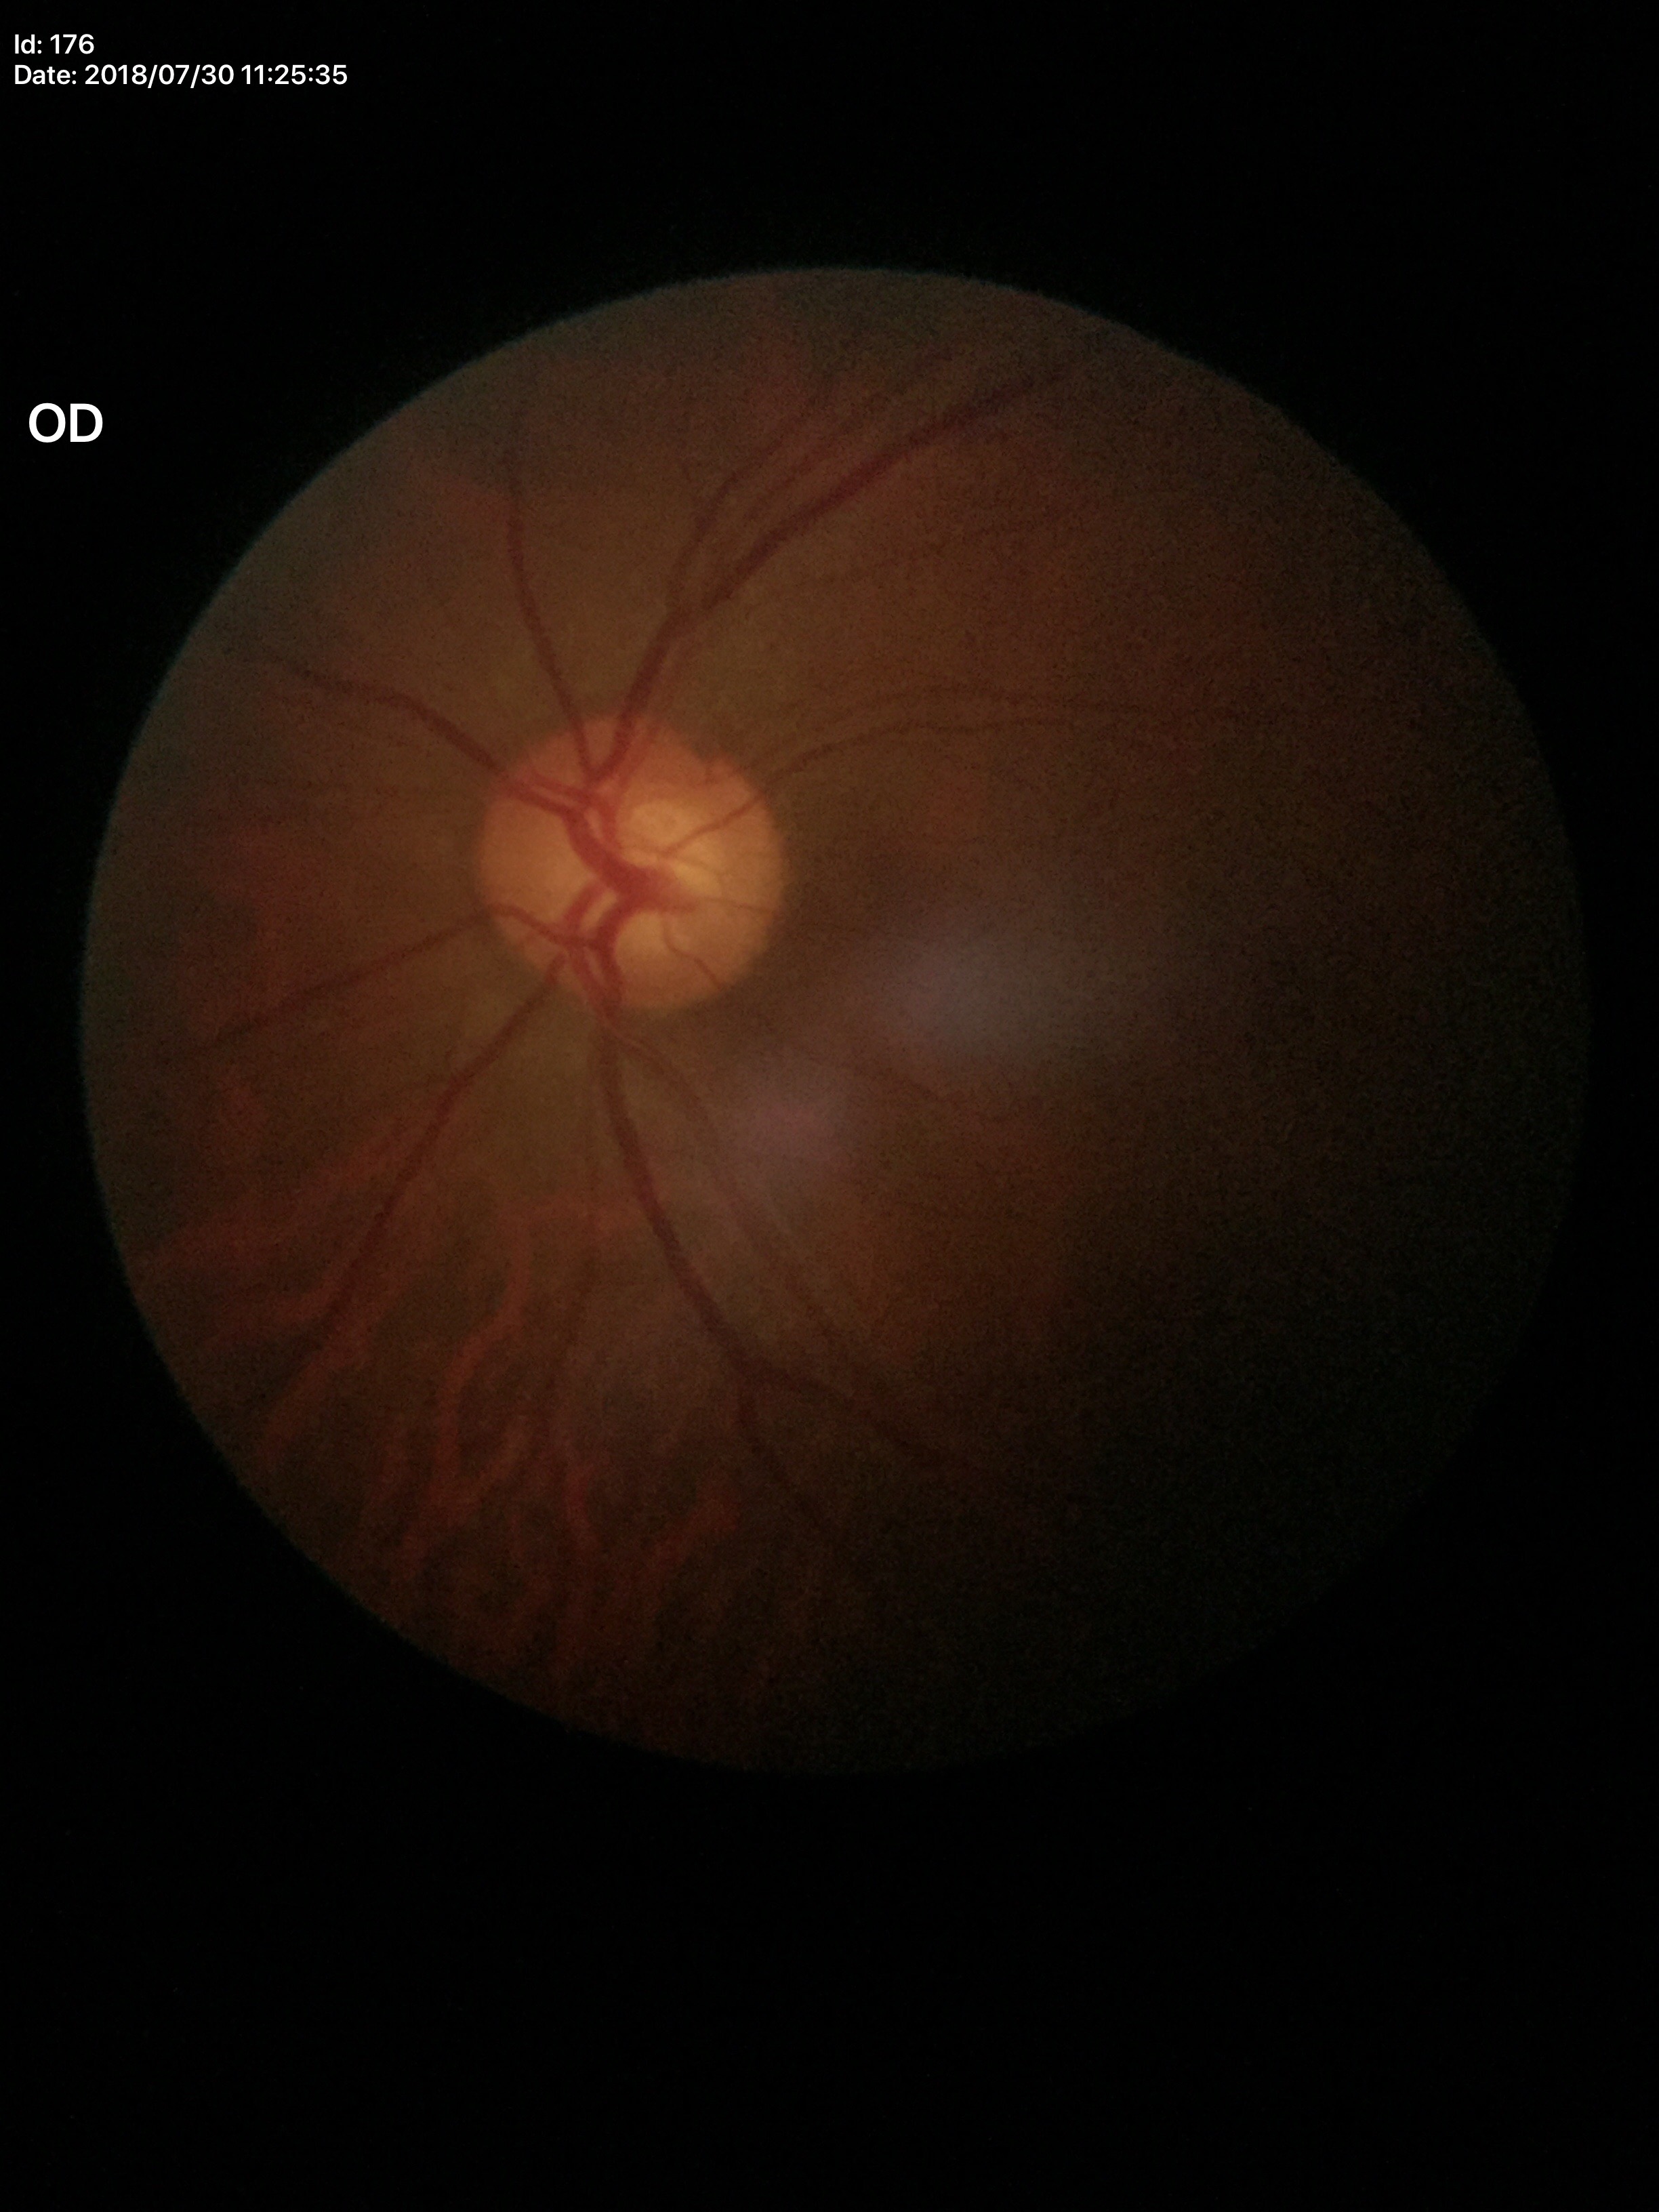 {"vcdr": "0.59", "glaucoma_decision": "negative"}